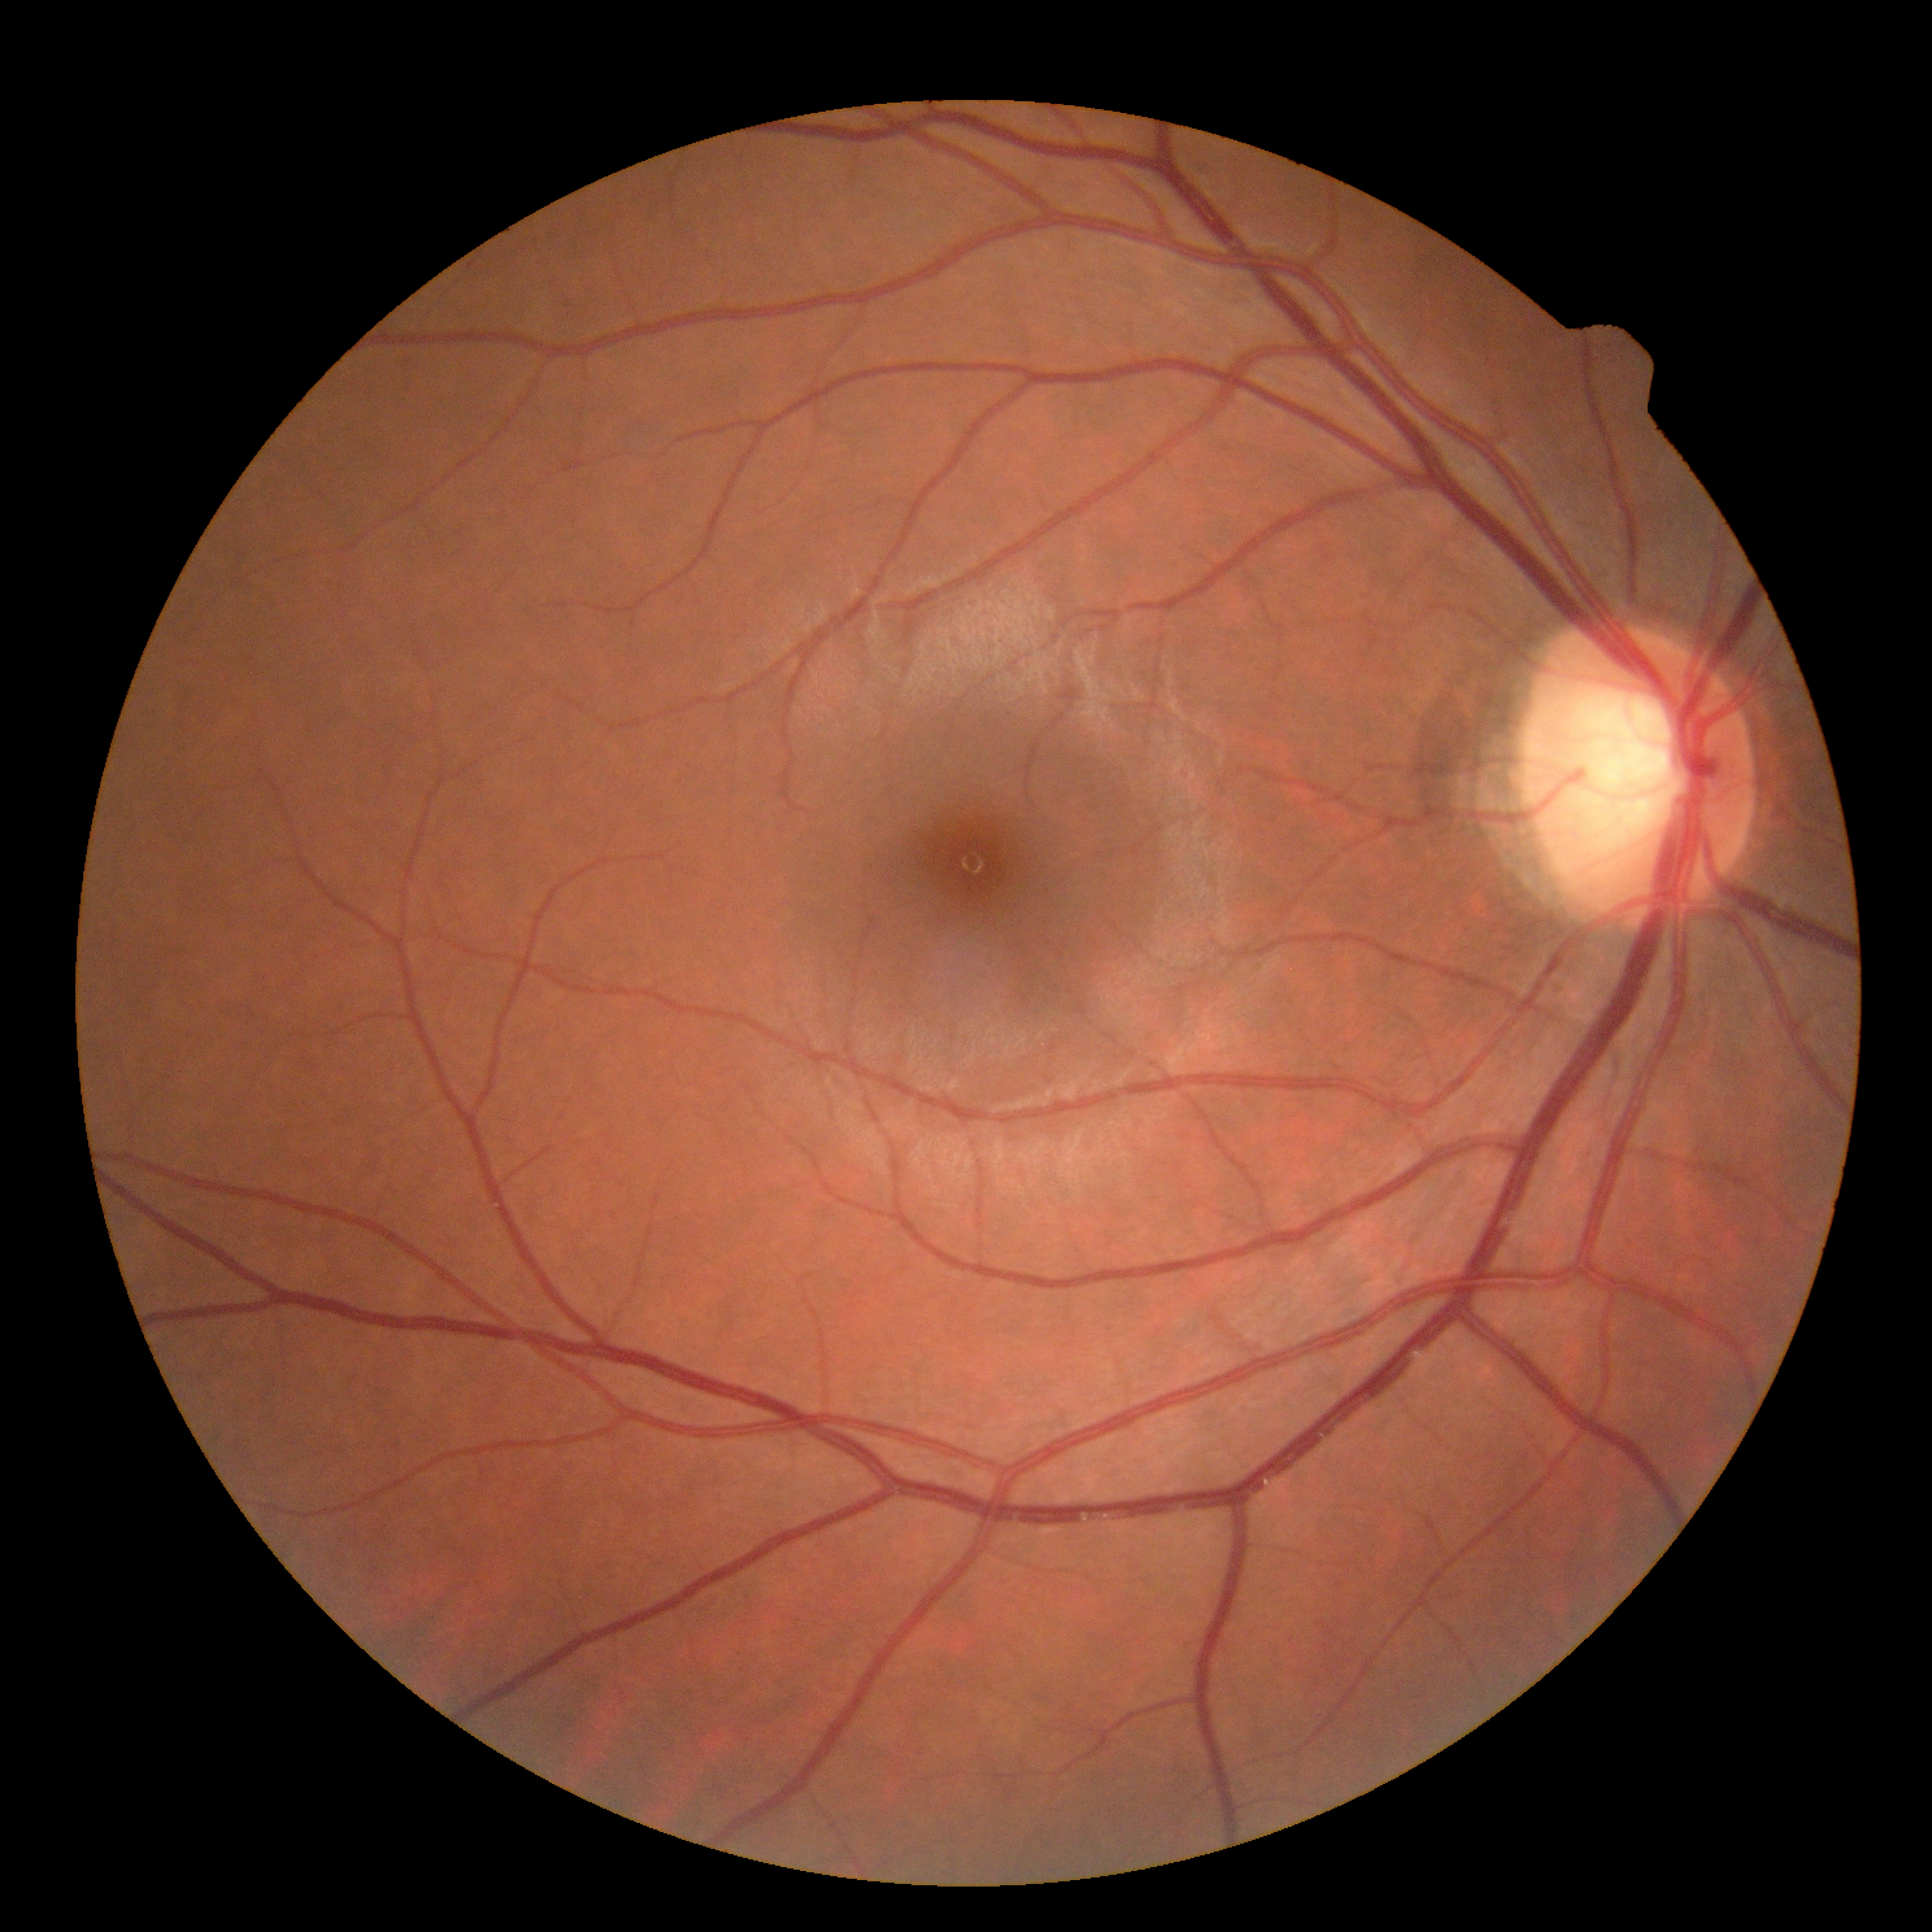
Diabetic retinopathy severity: 0/4.